Pediatric wide-field fundus photograph; 640 x 480 pixels — 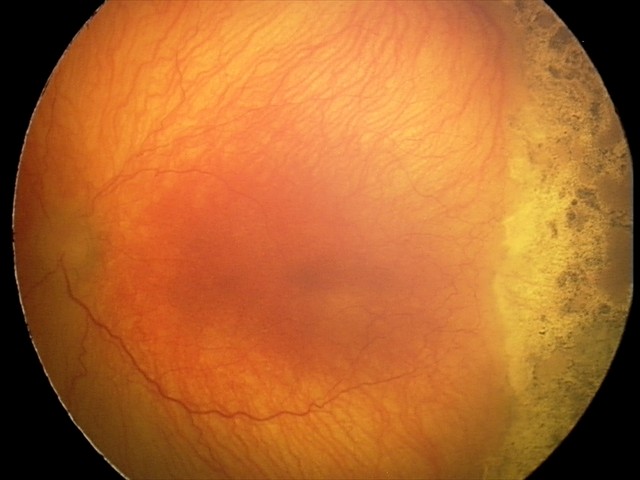 Diagnosis = aggressive ROP (A-ROP) | plus disease = present.